Color fundus image.
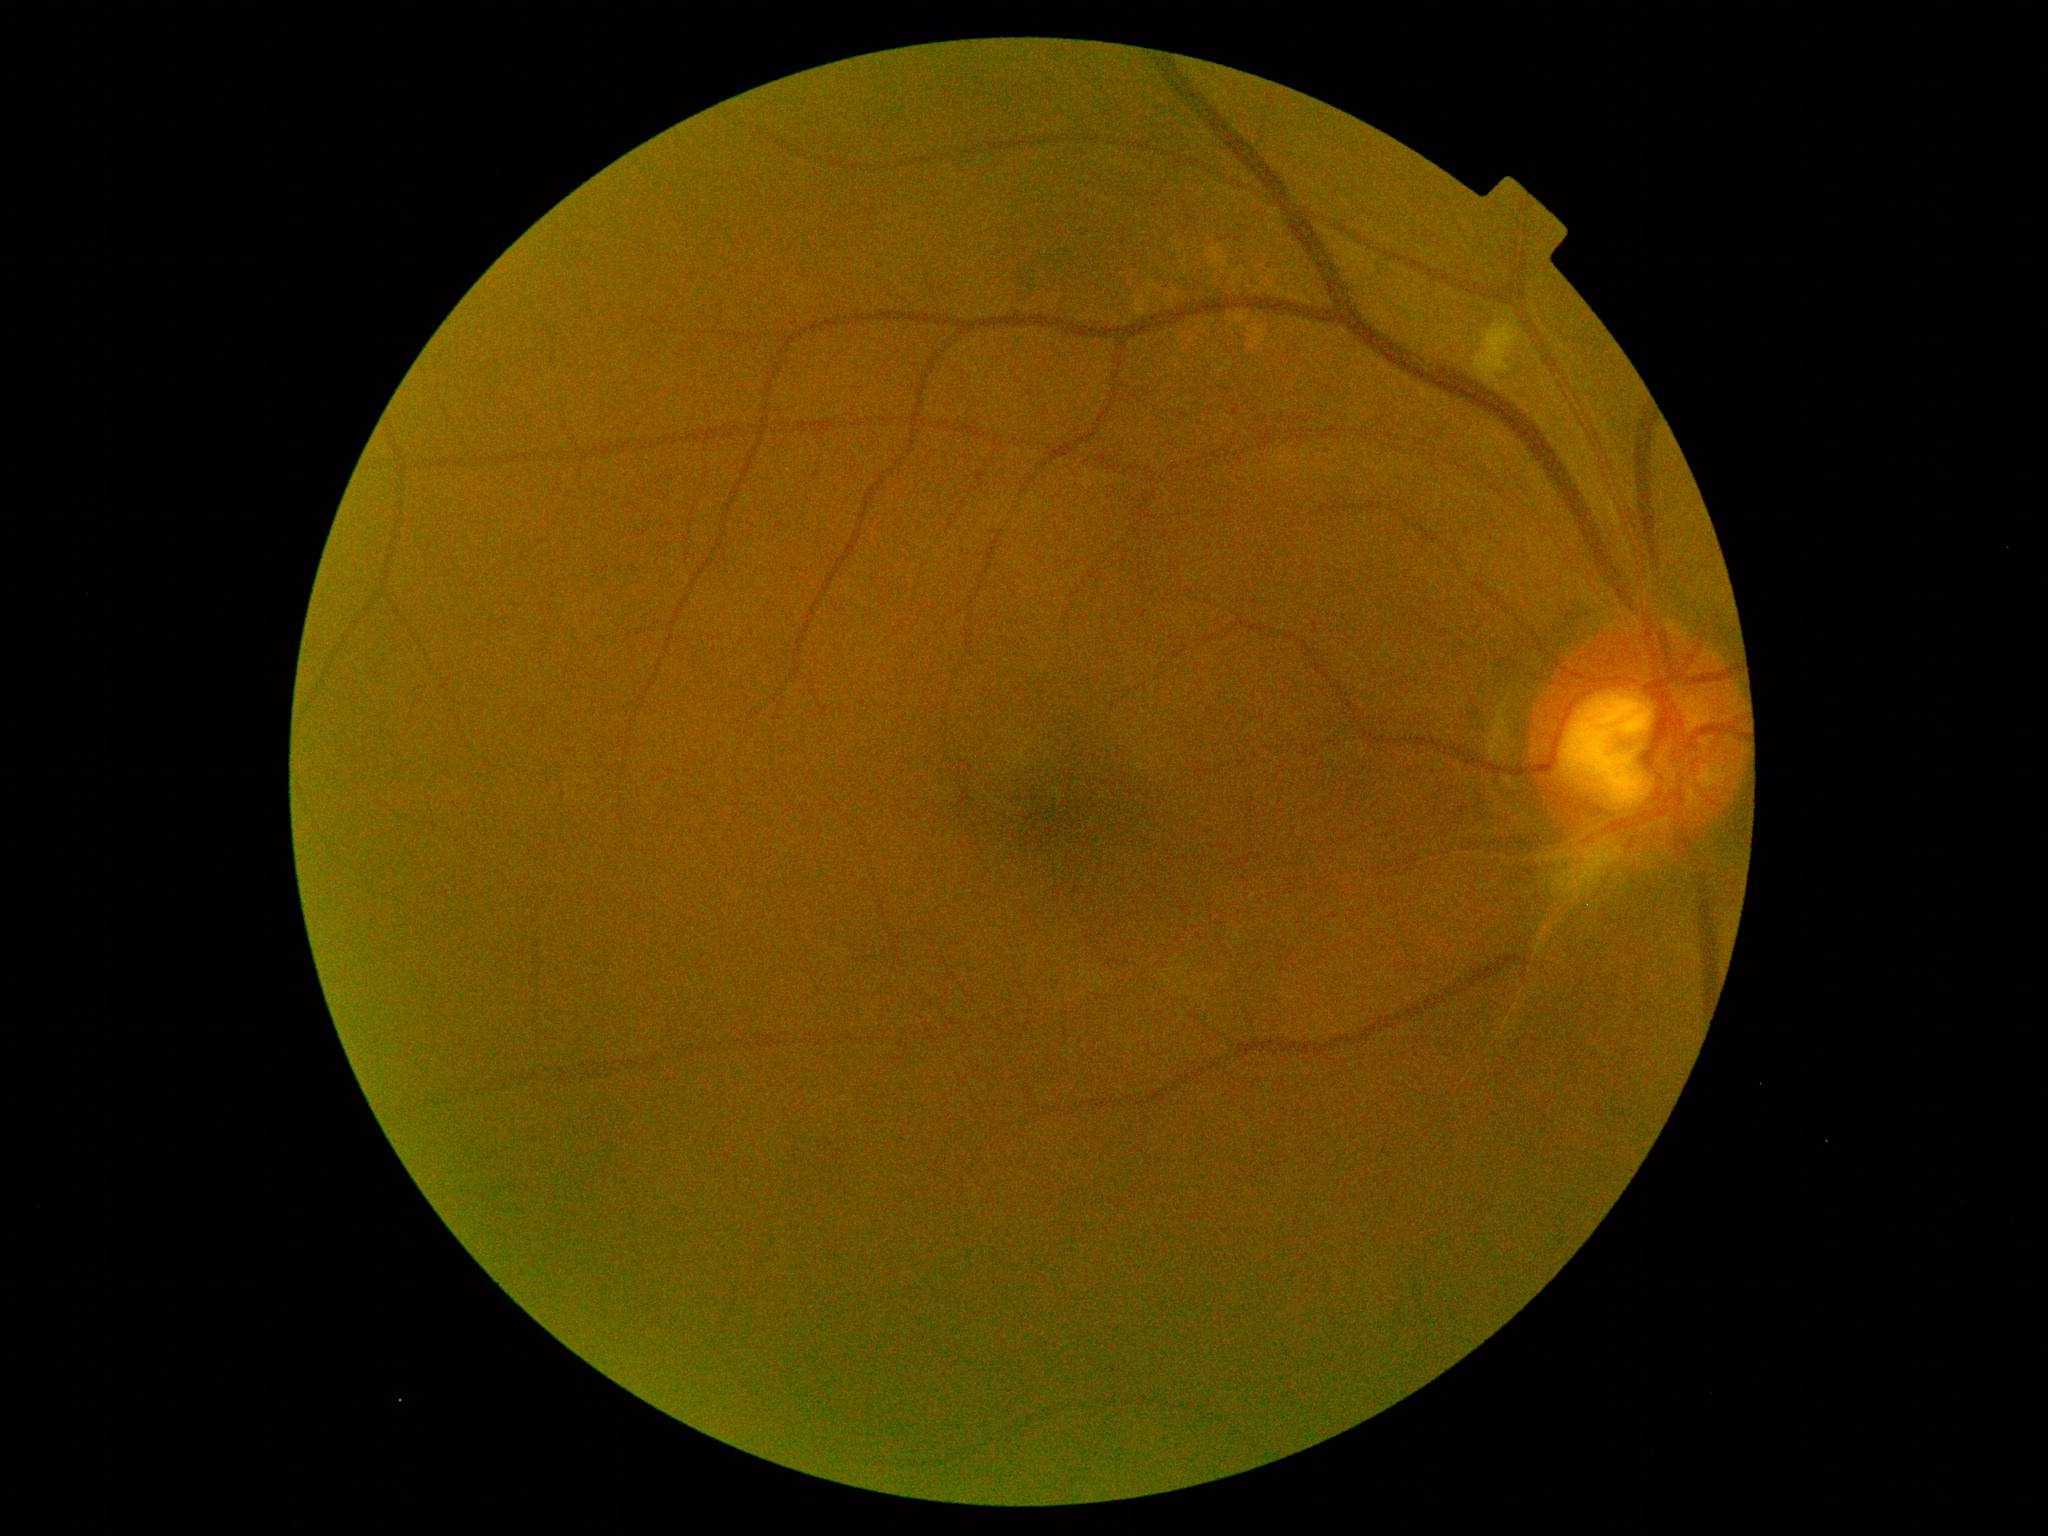
* DR class: non-proliferative diabetic retinopathy
* DR severity: 2